Color fundus image
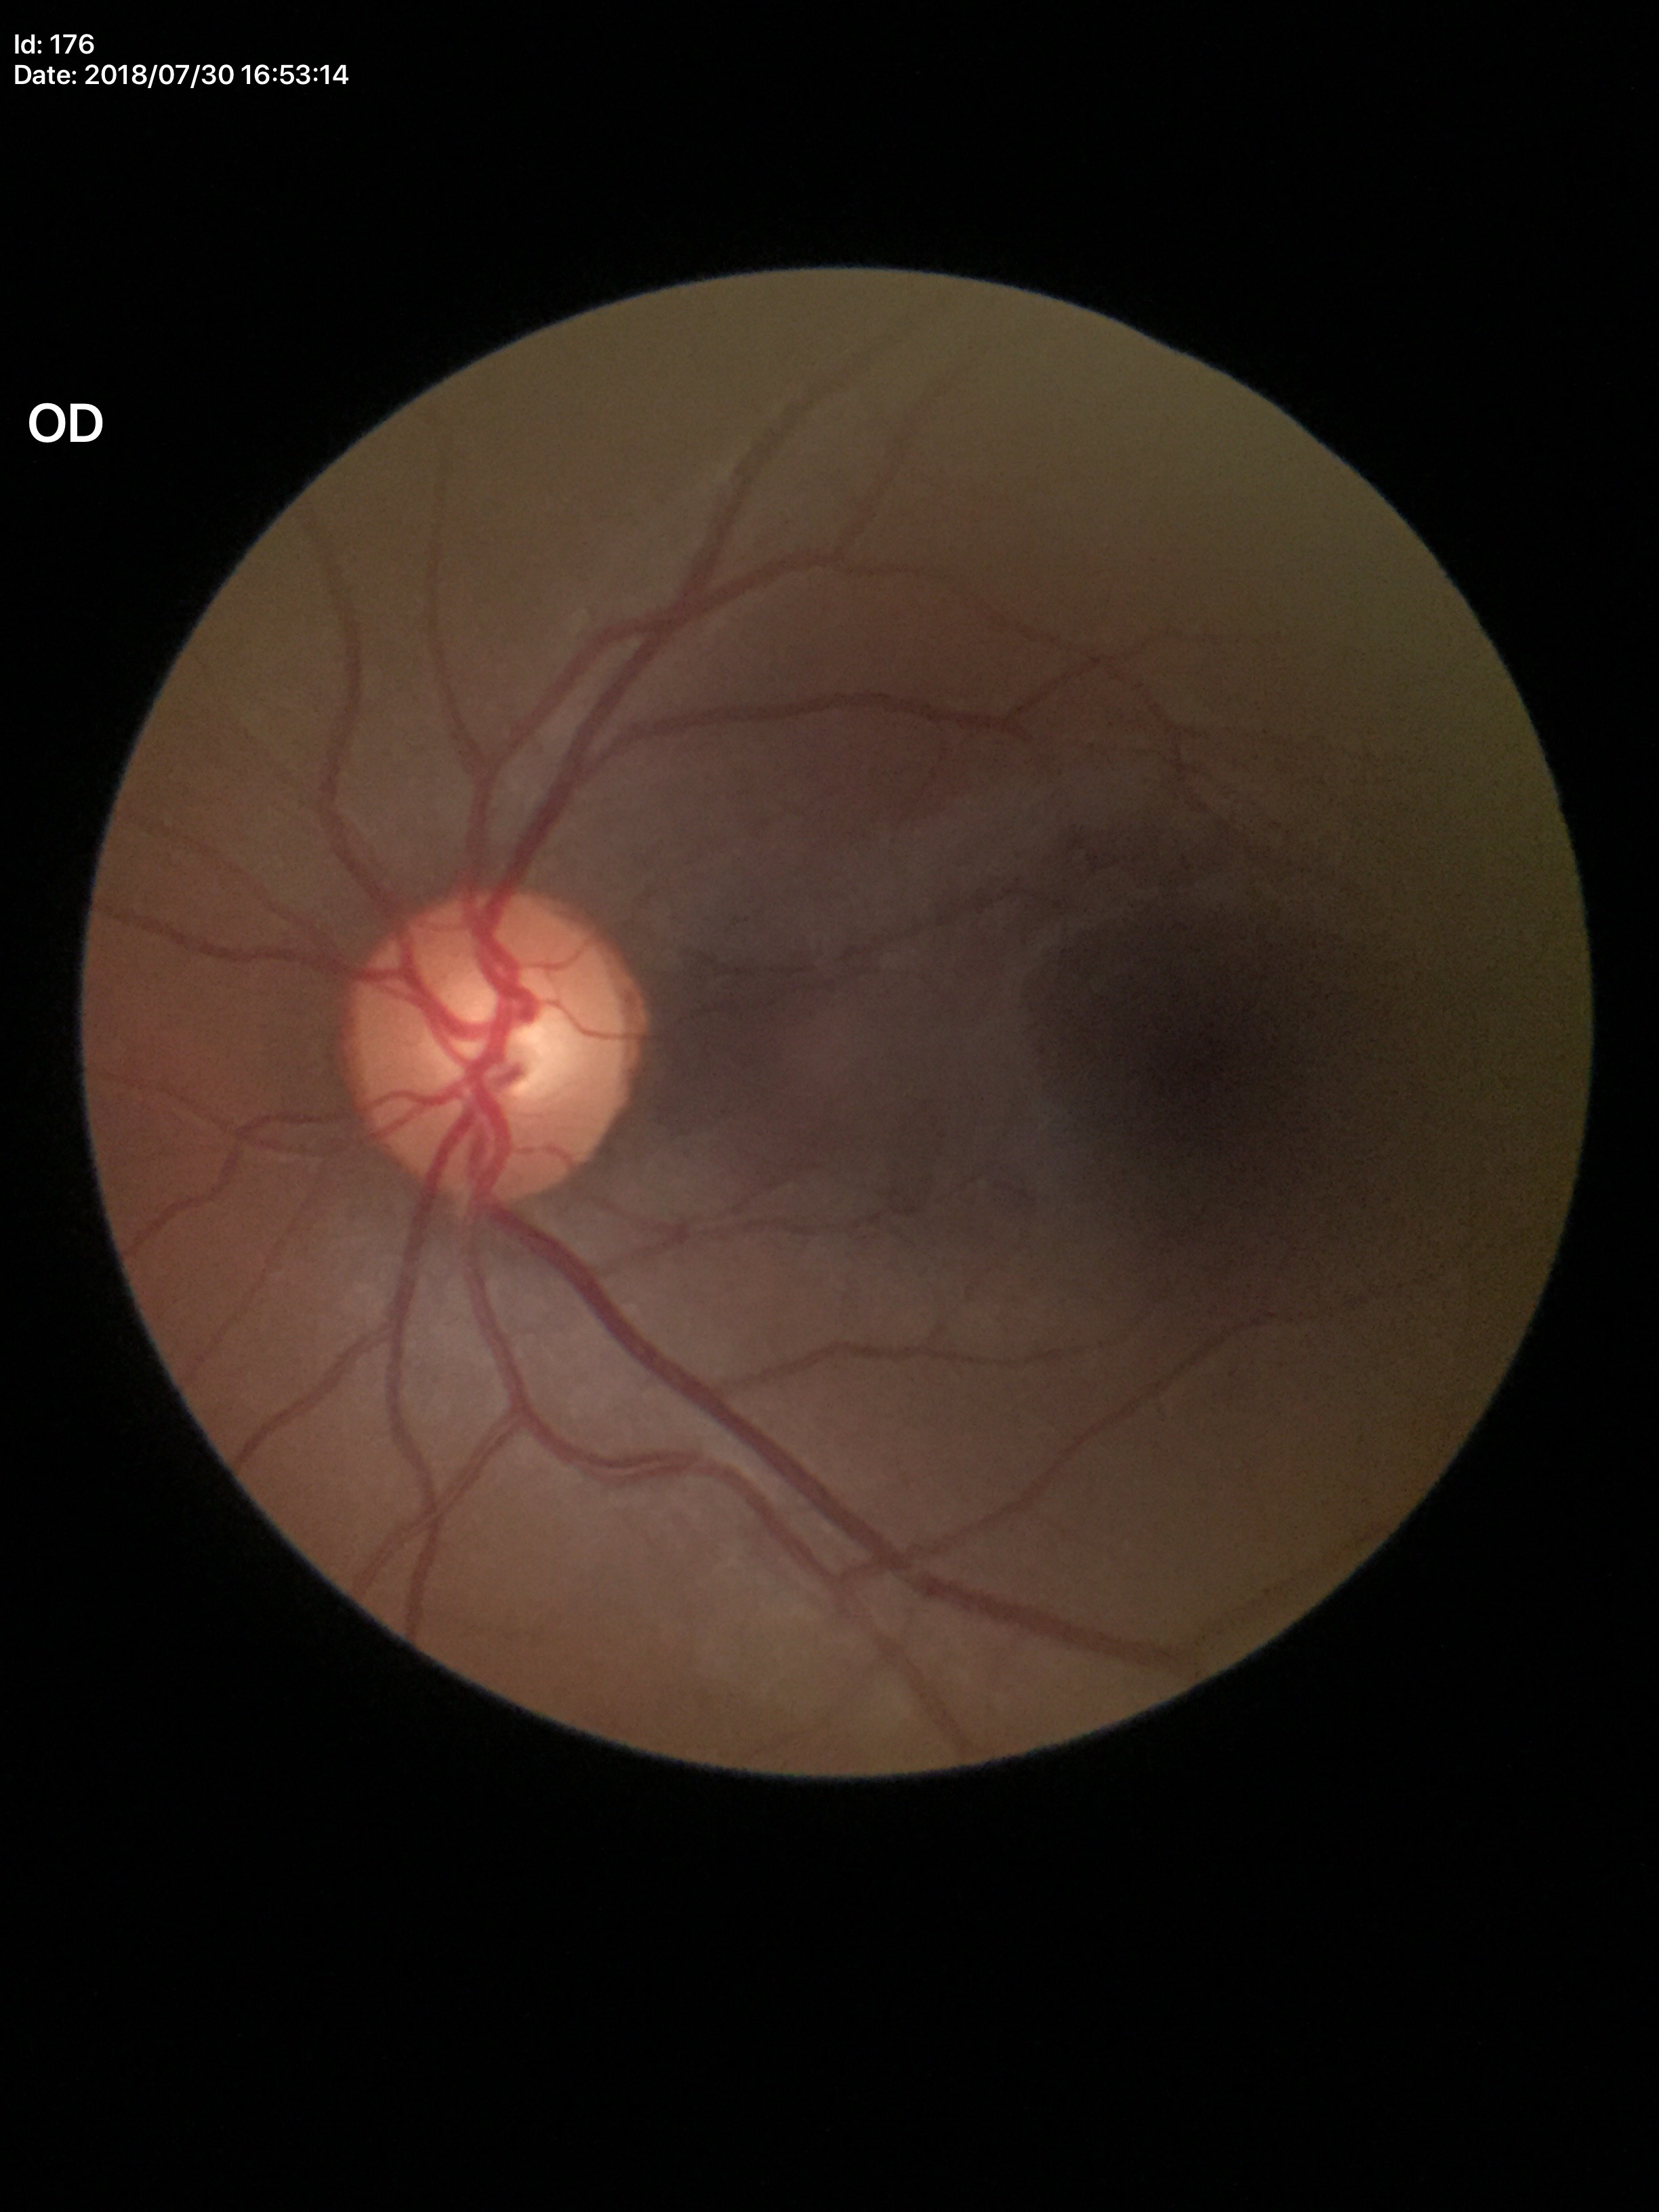

No evidence of glaucoma (1/5 graders called glaucoma suspect).
VCDR: 0.55.